Fundus photo:
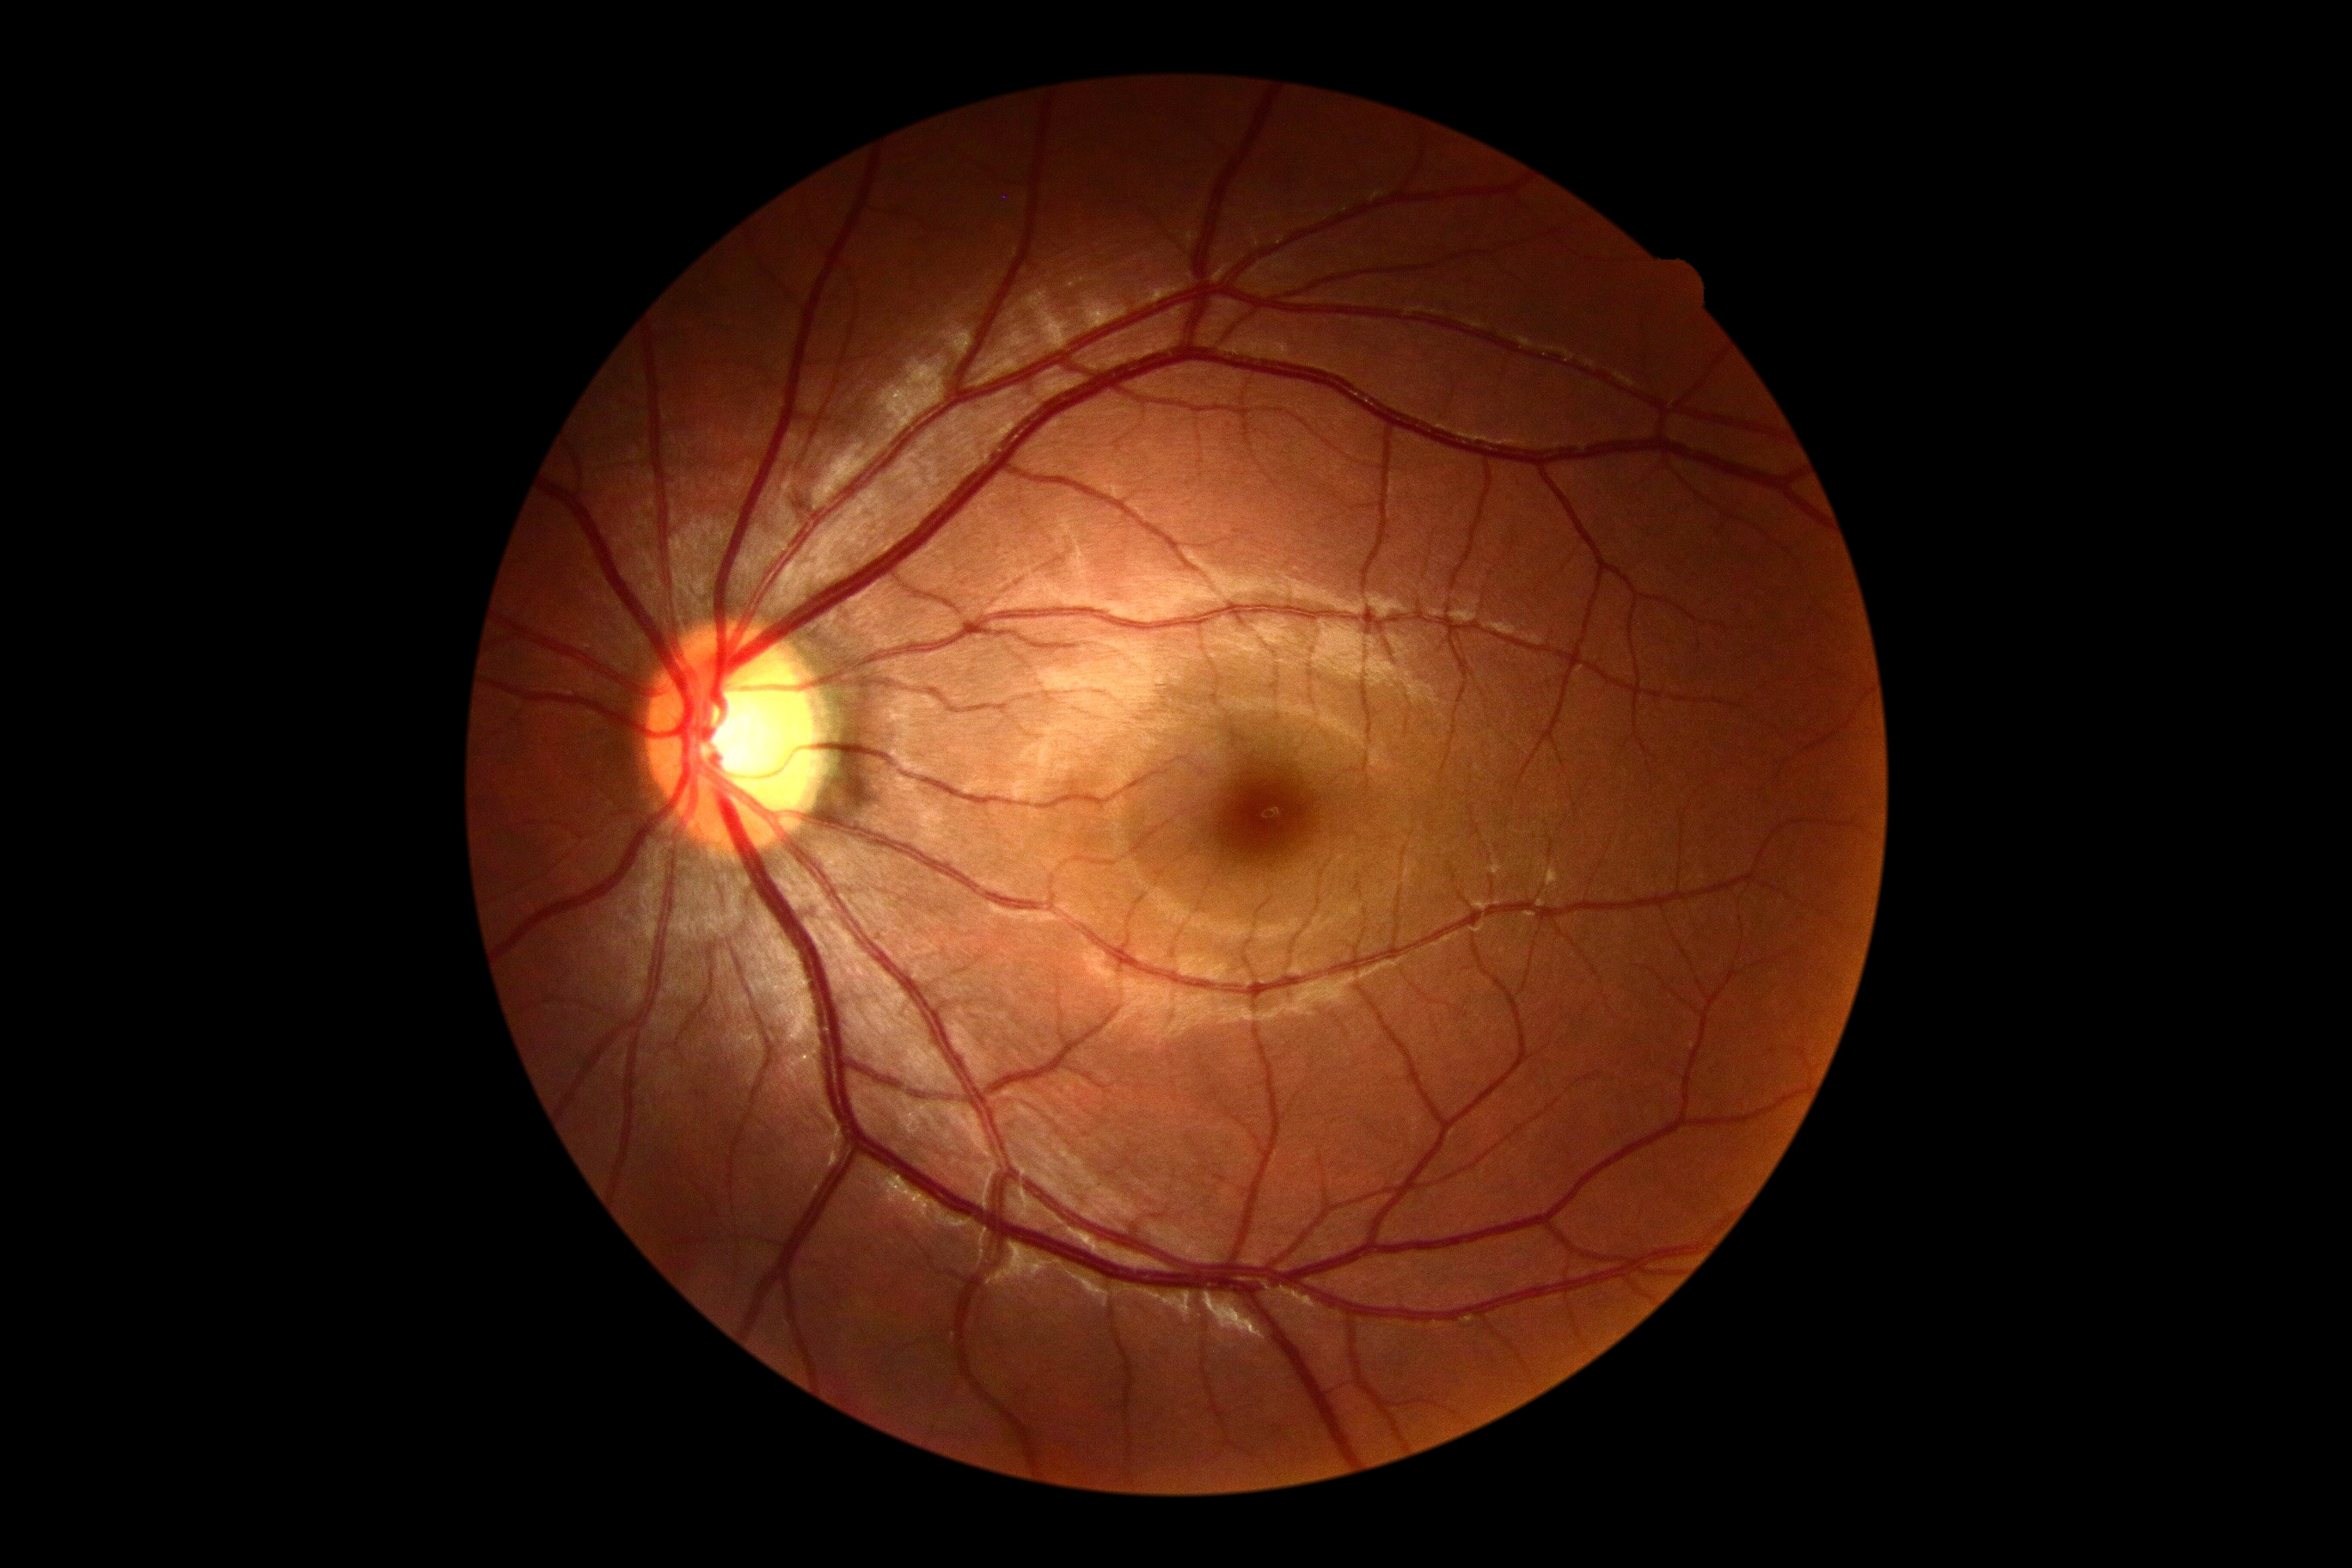 diabetic retinopathy (DR): grade 0.